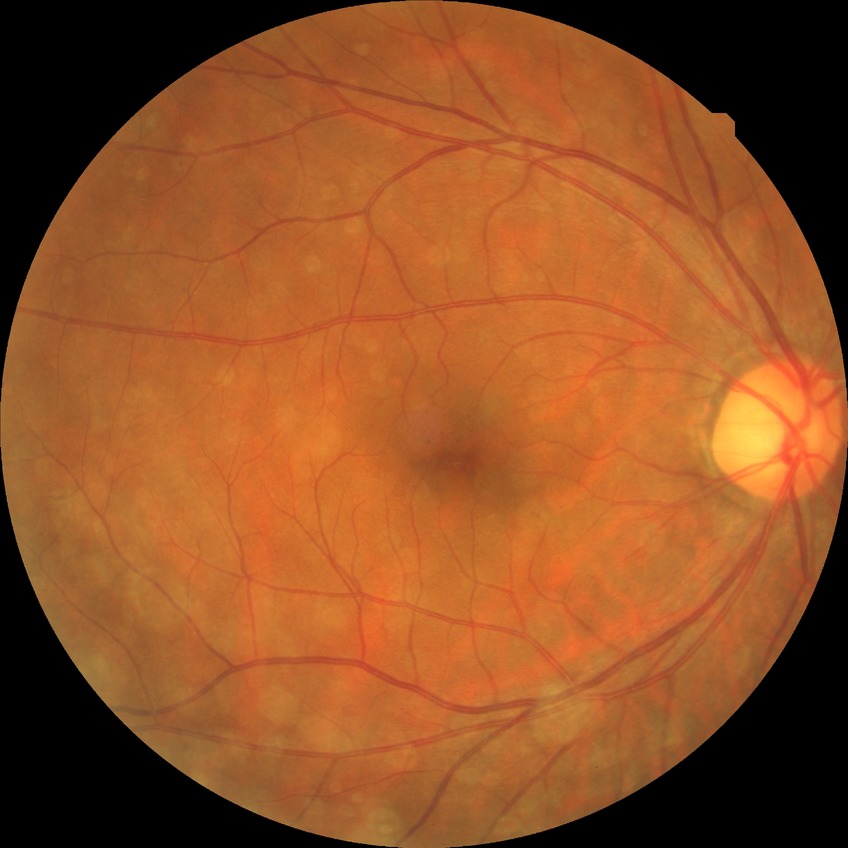
DR class: non-proliferative diabetic retinopathy. Diabetic retinopathy grade is simple diabetic retinopathy.